NIDEK AFC-230 · posterior pole color fundus photograph · nonmydriatic fundus photograph: 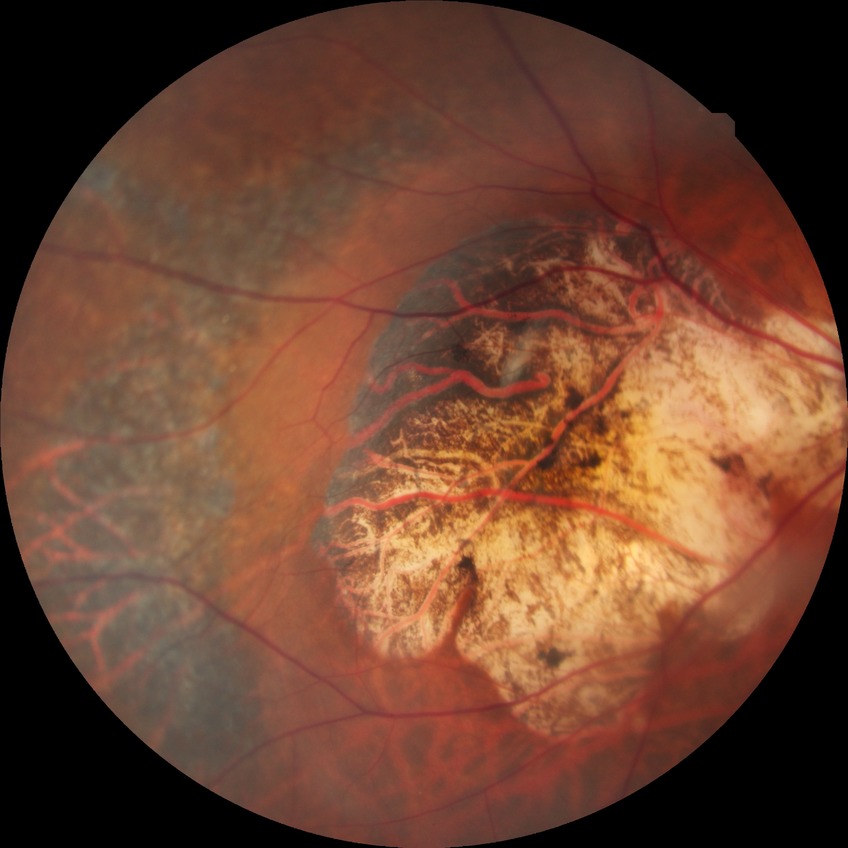 Diabetic retinopathy grade: no diabetic retinopathy.